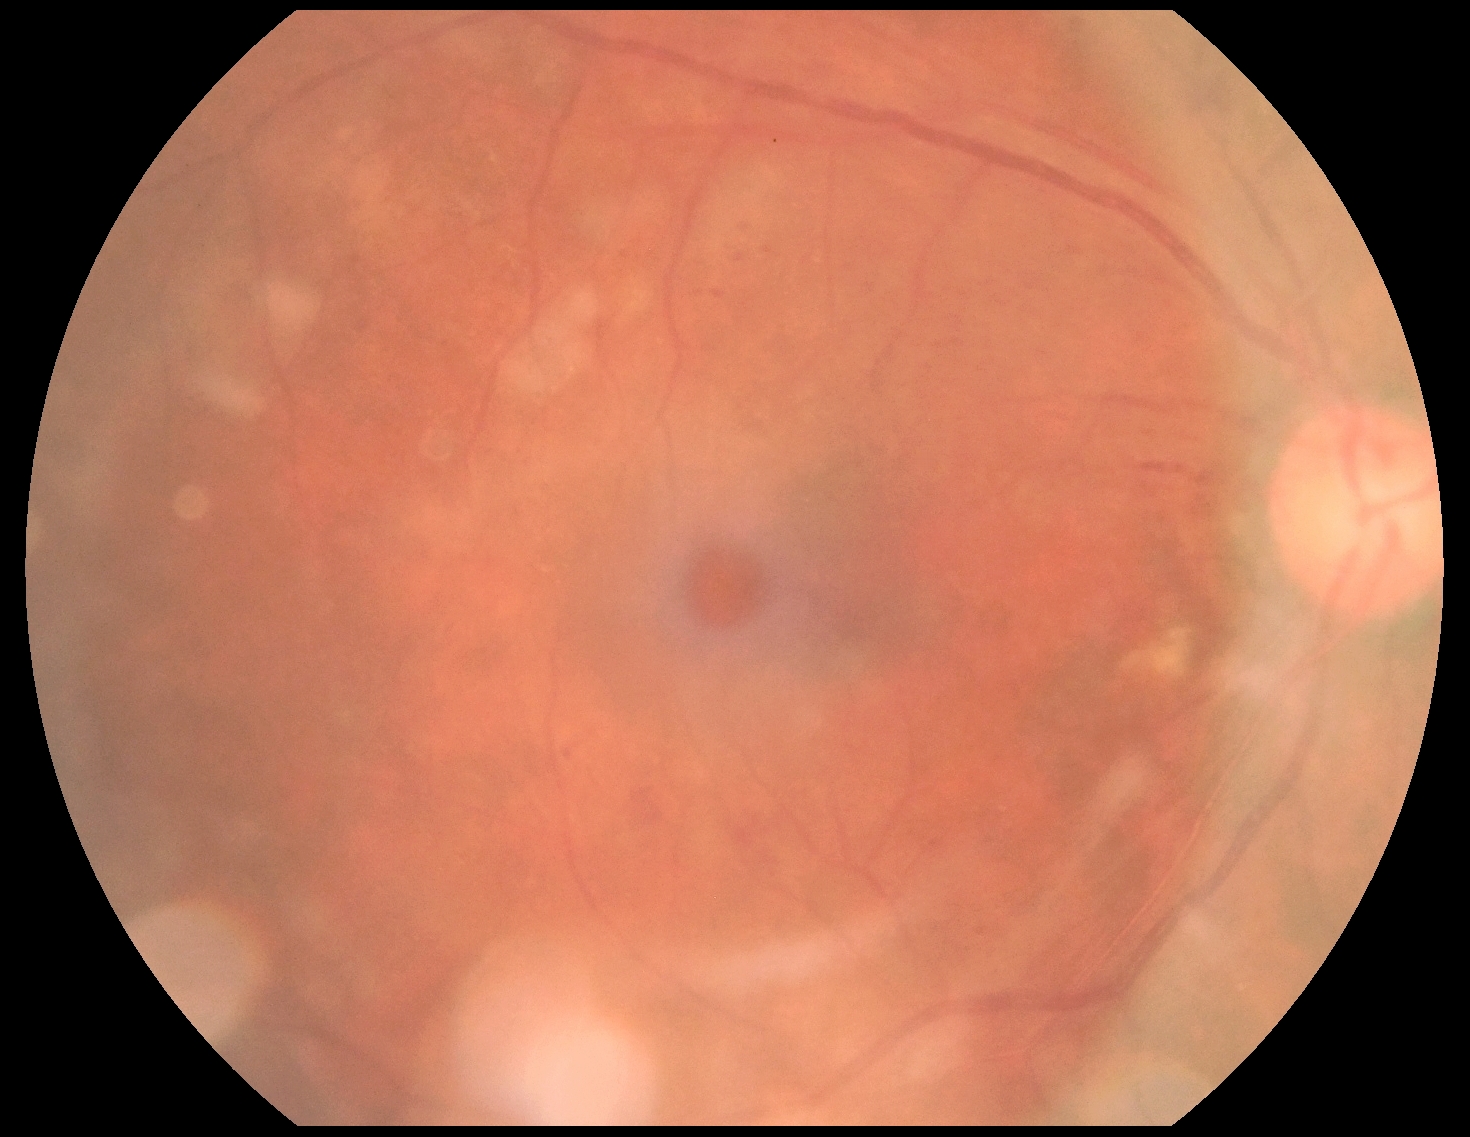

Retinopathy: grade 2.